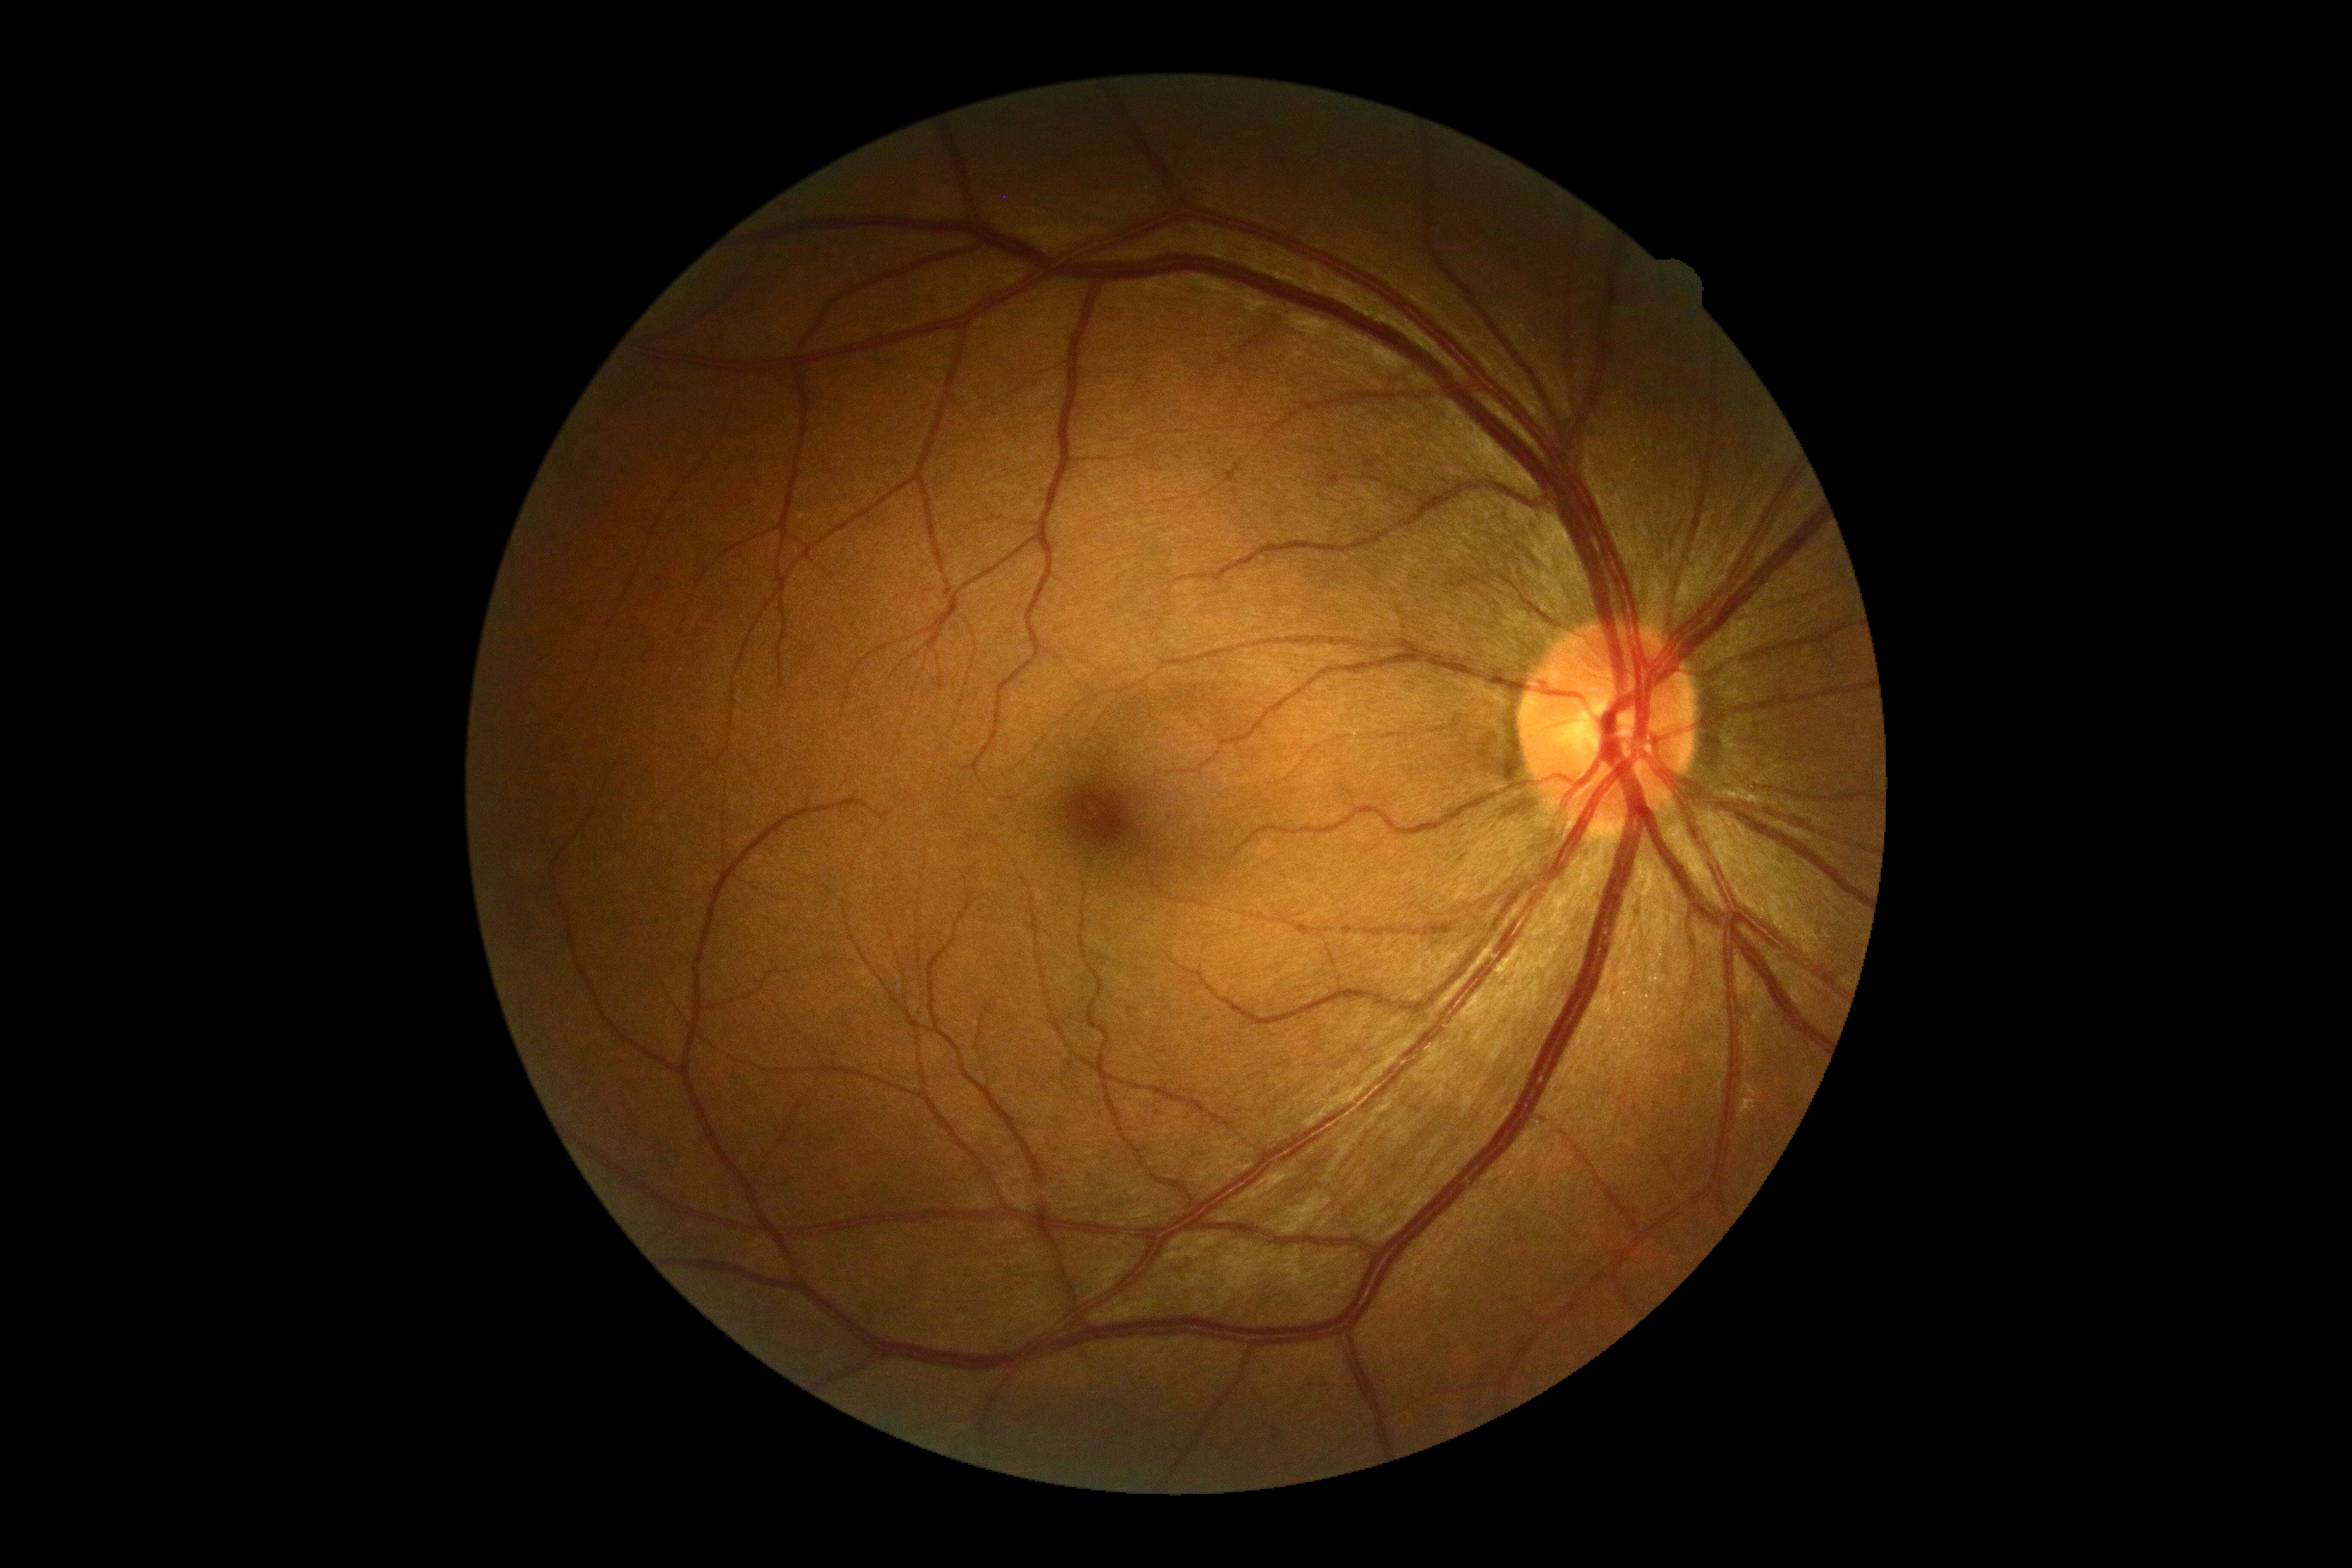 Annotations:
- diabetic retinopathy severity: grade 0 (no apparent retinopathy) — no visible signs of diabetic retinopathy
- DR impression: no apparent DR